Graded on the modified Davis scale
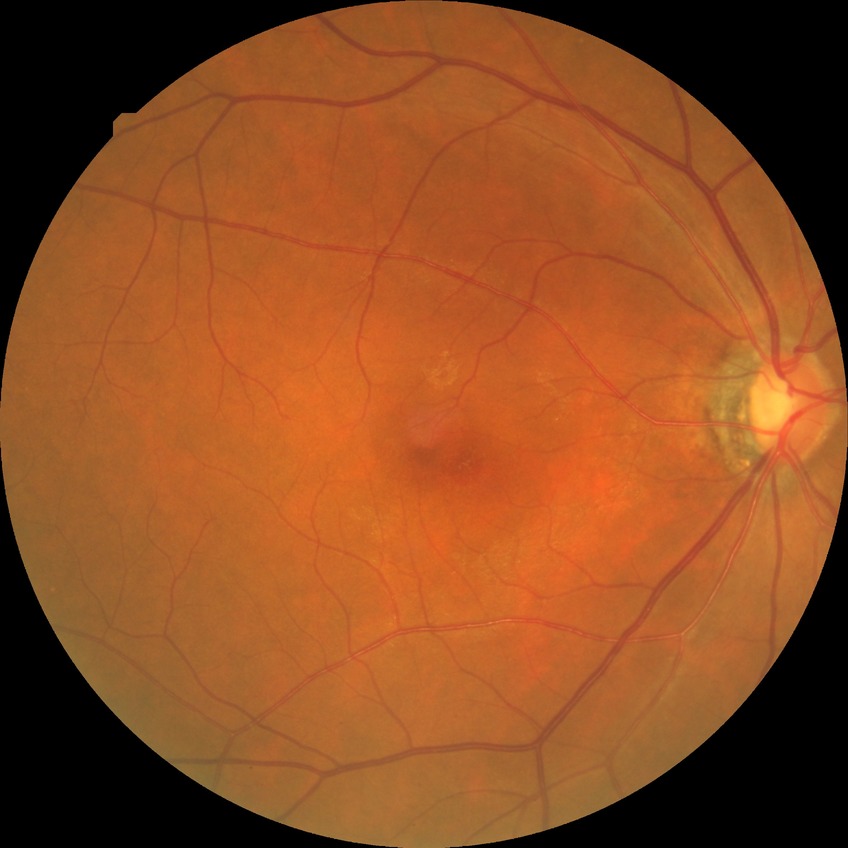   davis_grade: NDR (no diabetic retinopathy)